240x240 — 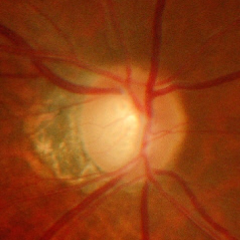 Assessment = advanced-stage glaucoma.